2228 x 1652 pixels · acquired with a Topcon TRC-50DX · retinal fundus photograph
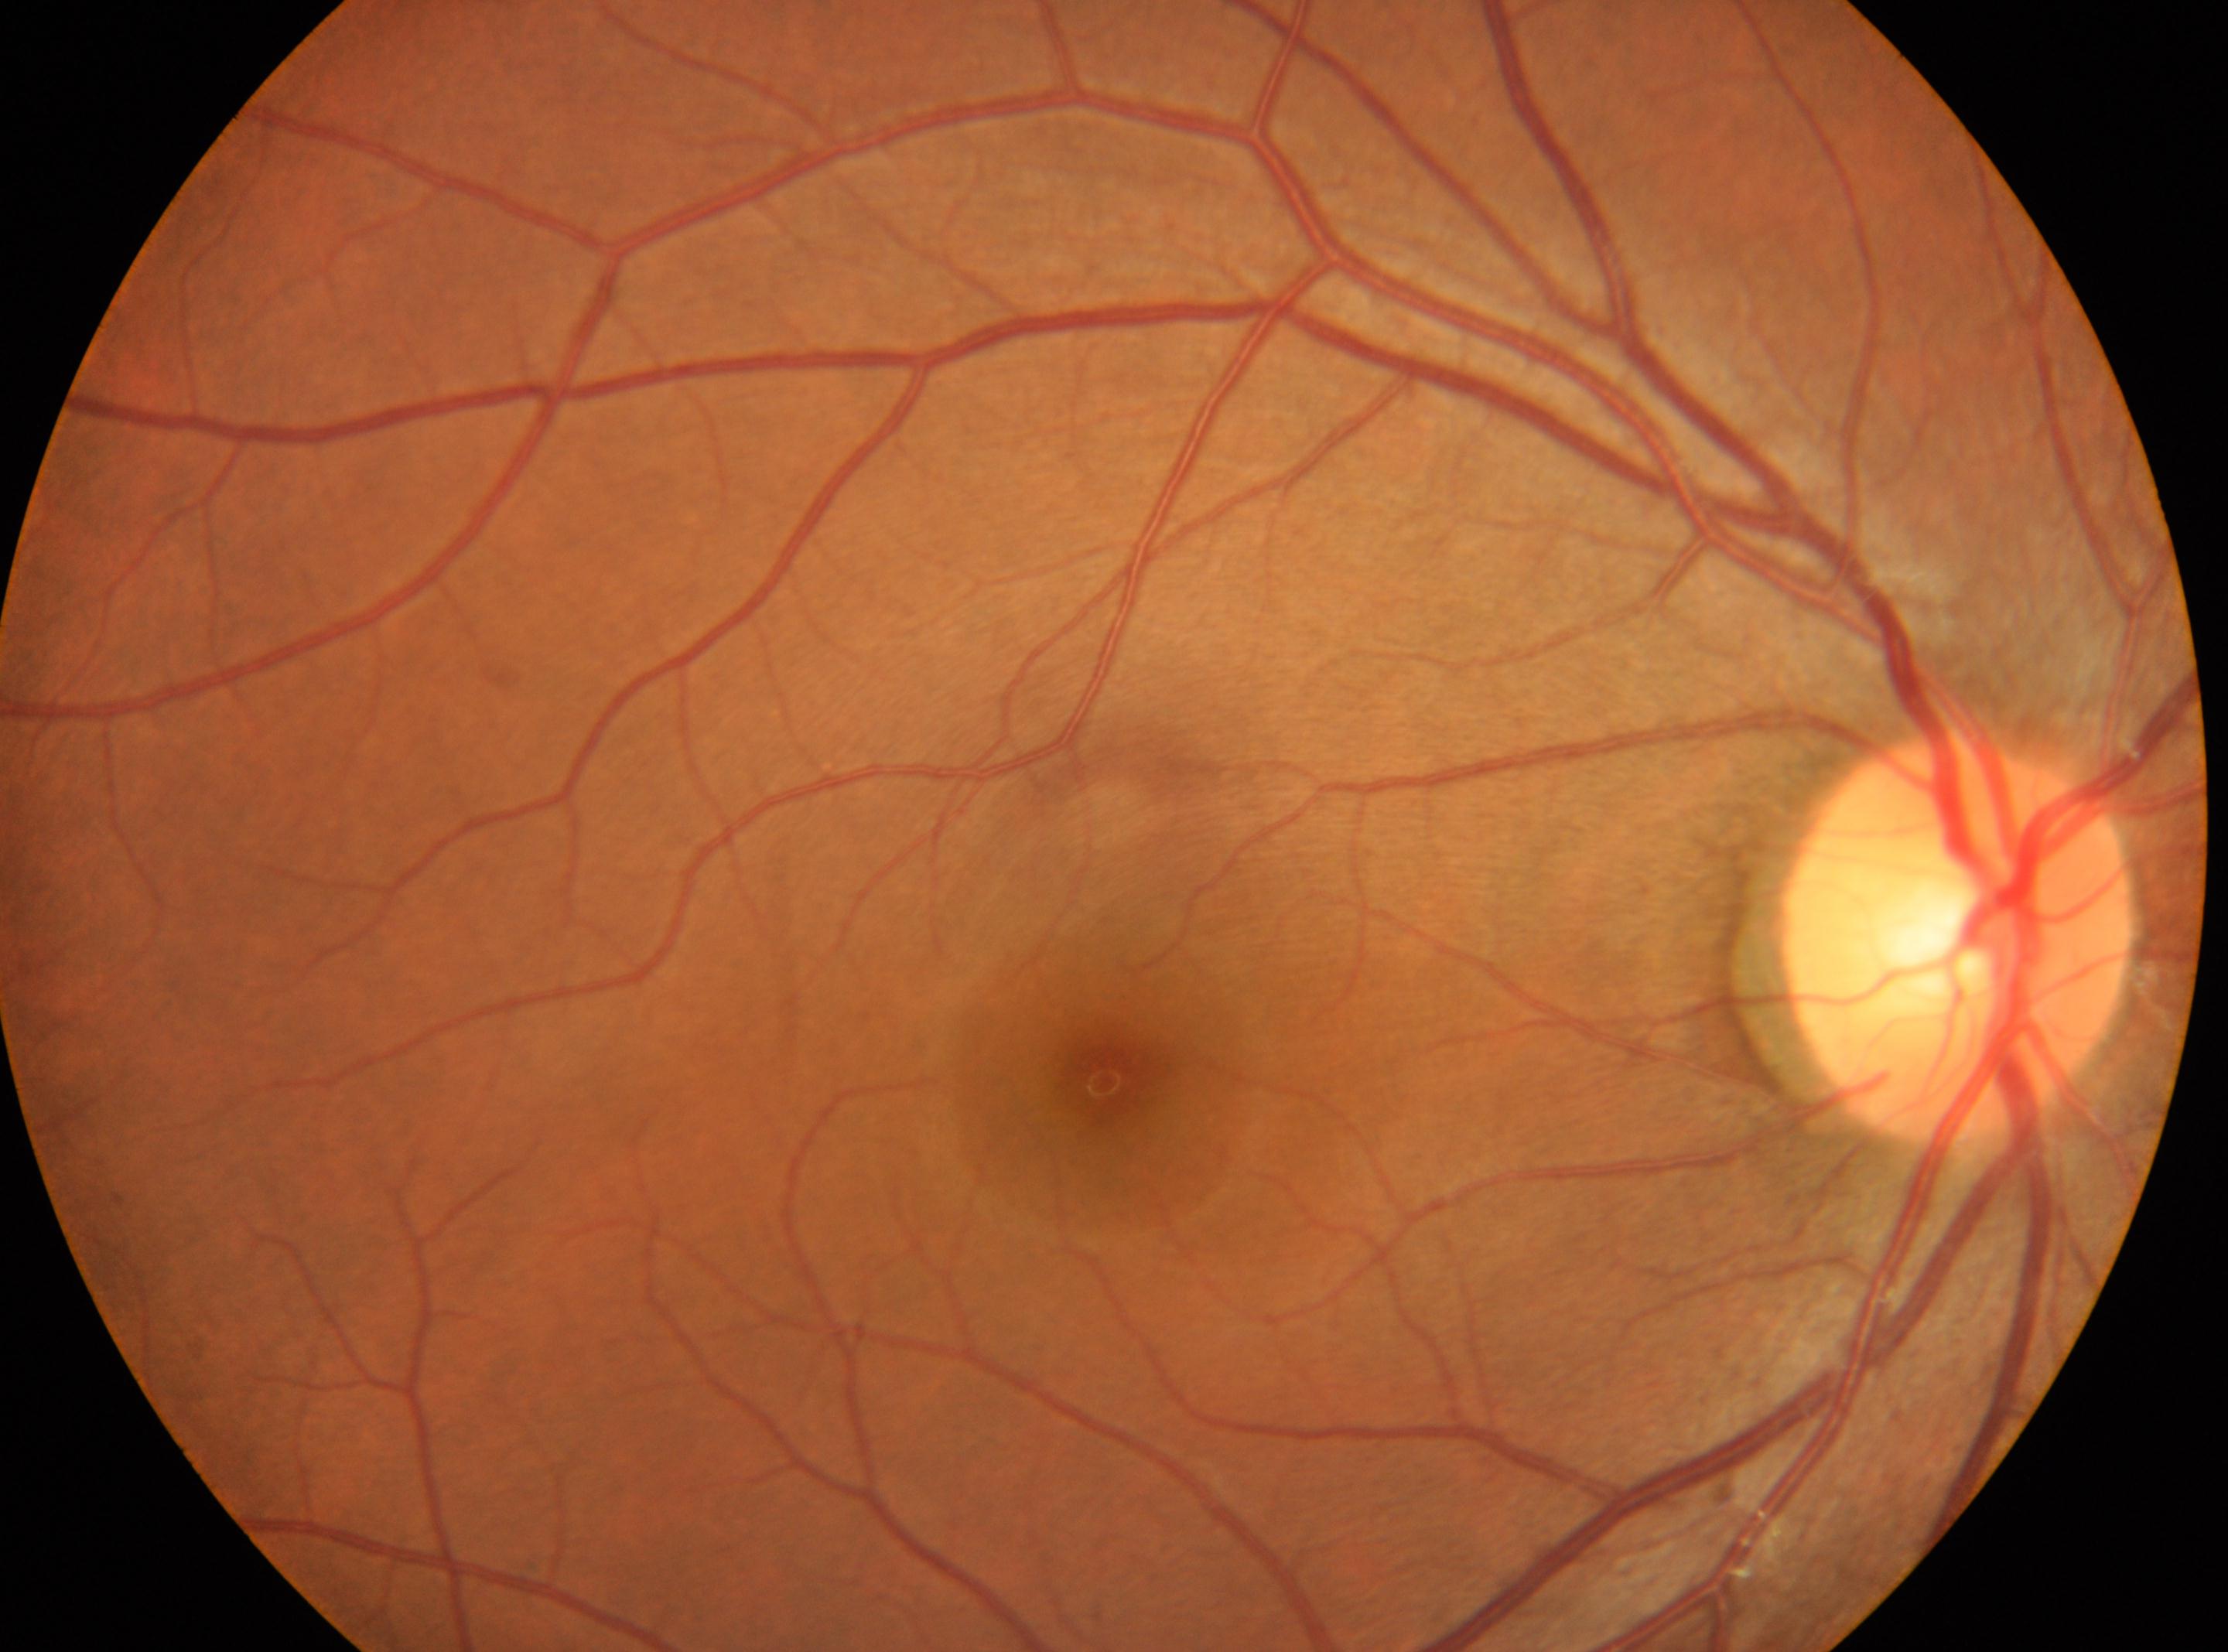

DR grade: 0. Eye: oculus dexter. Fovea located at 1105, 1083. ONH: 1958, 940.